45° FOV · color fundus photograph · 2048 by 1536 pixels:
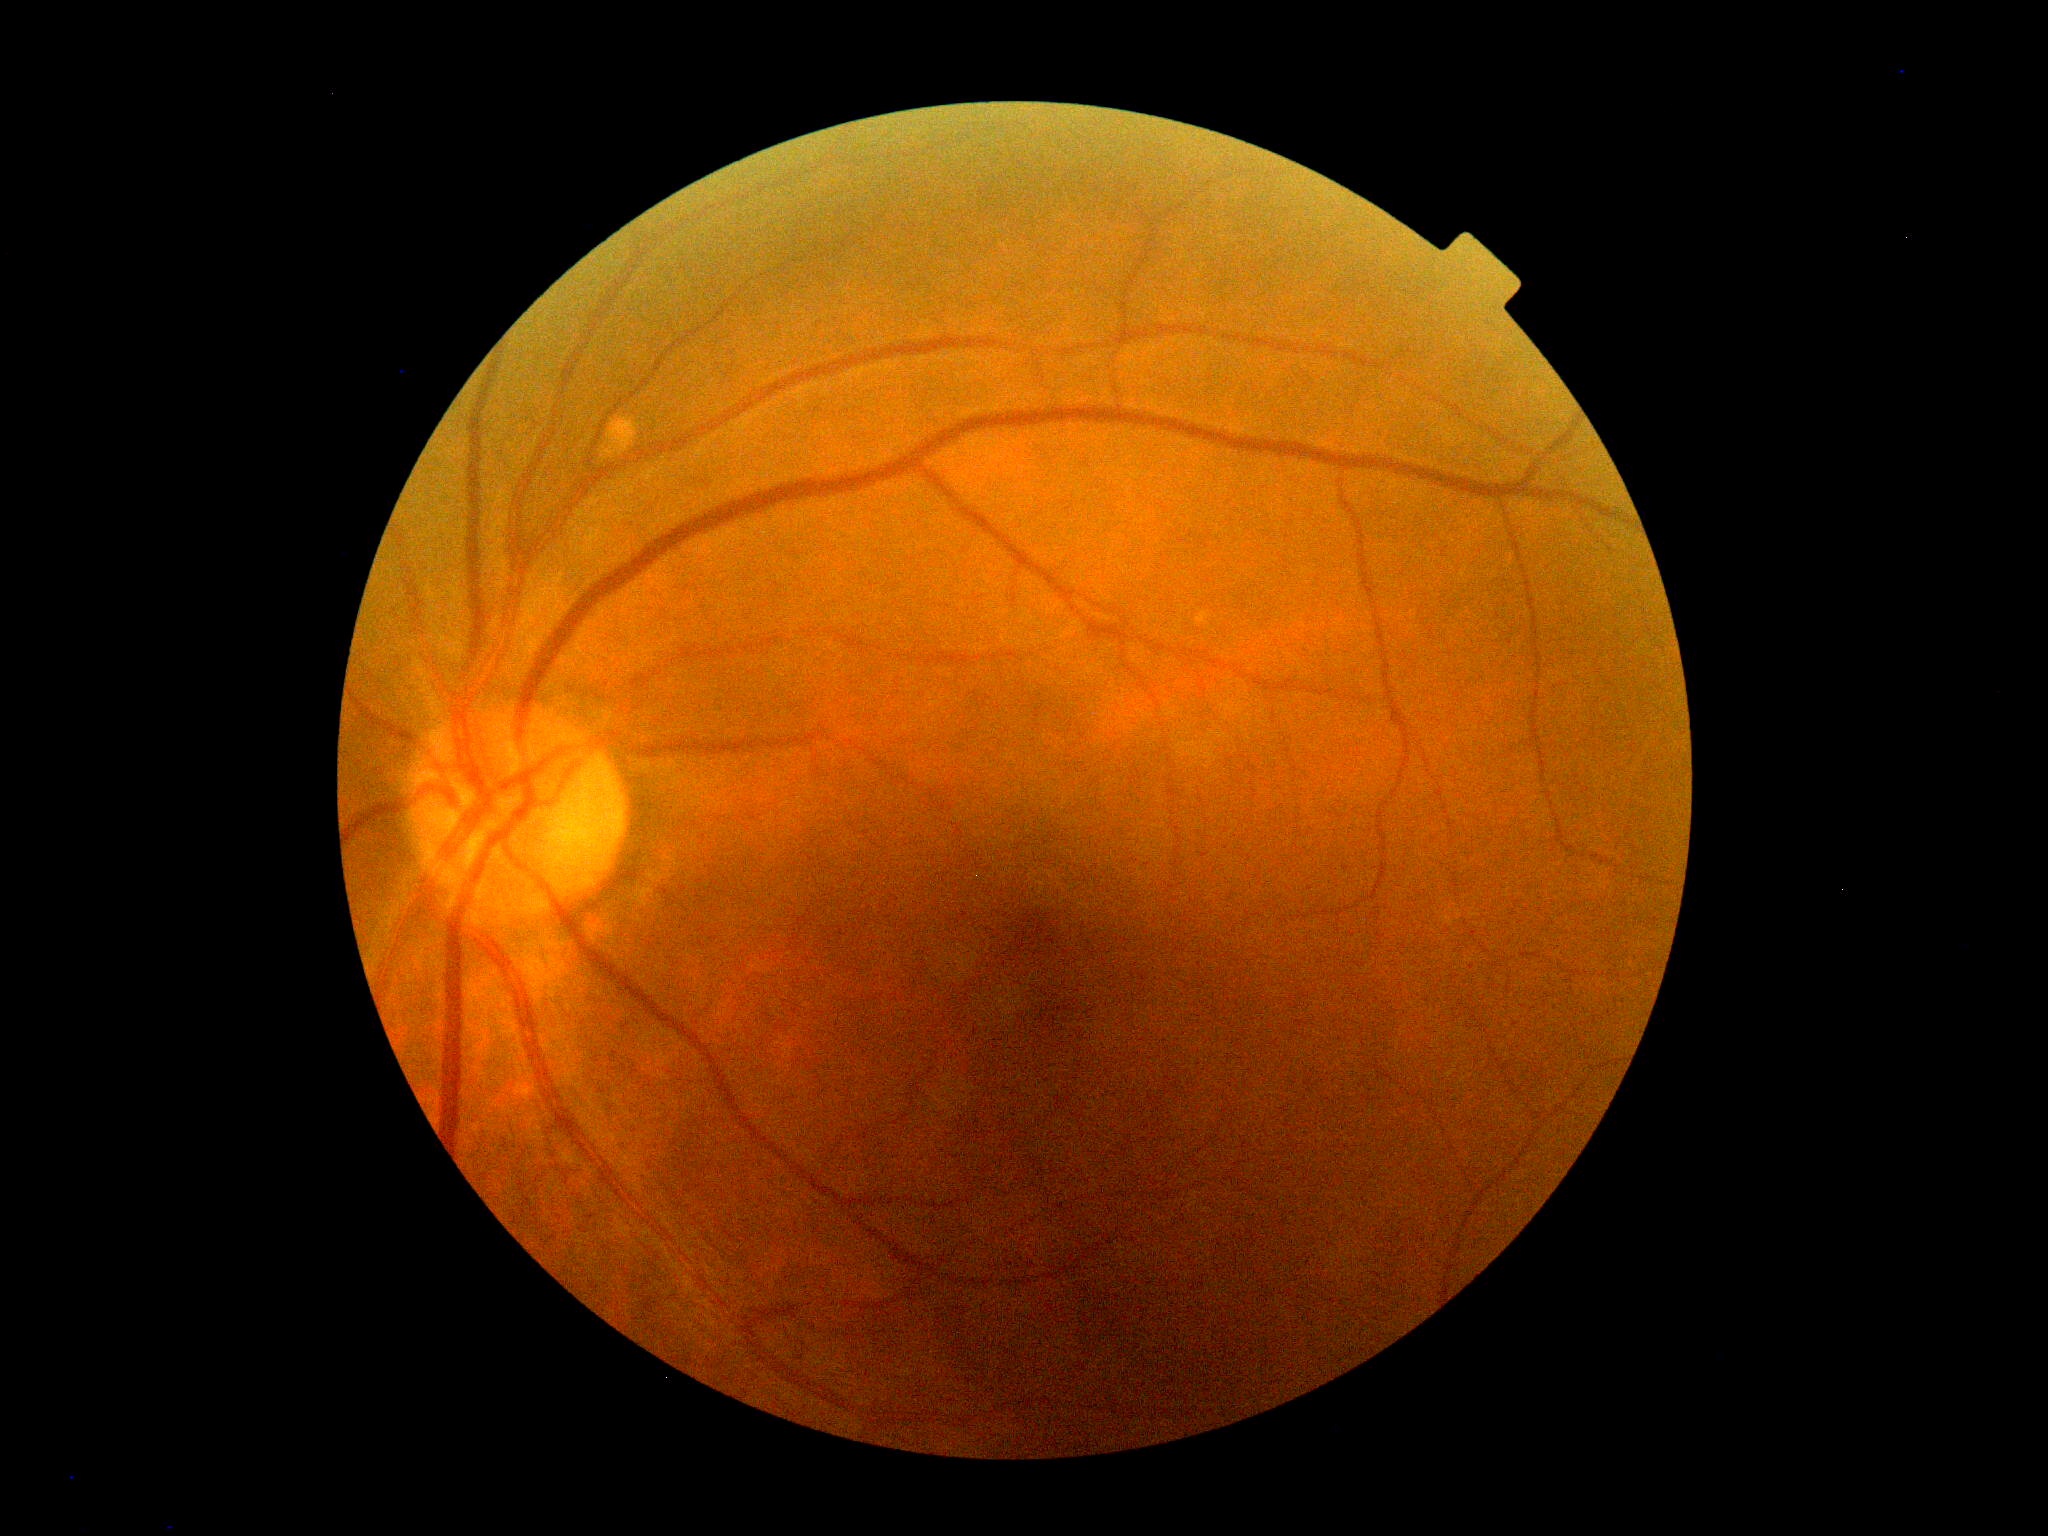

diabetic retinopathy (DR) = grade 0 (no apparent retinopathy).